No pharmacologic dilation · camera: NIDEK AFC-230
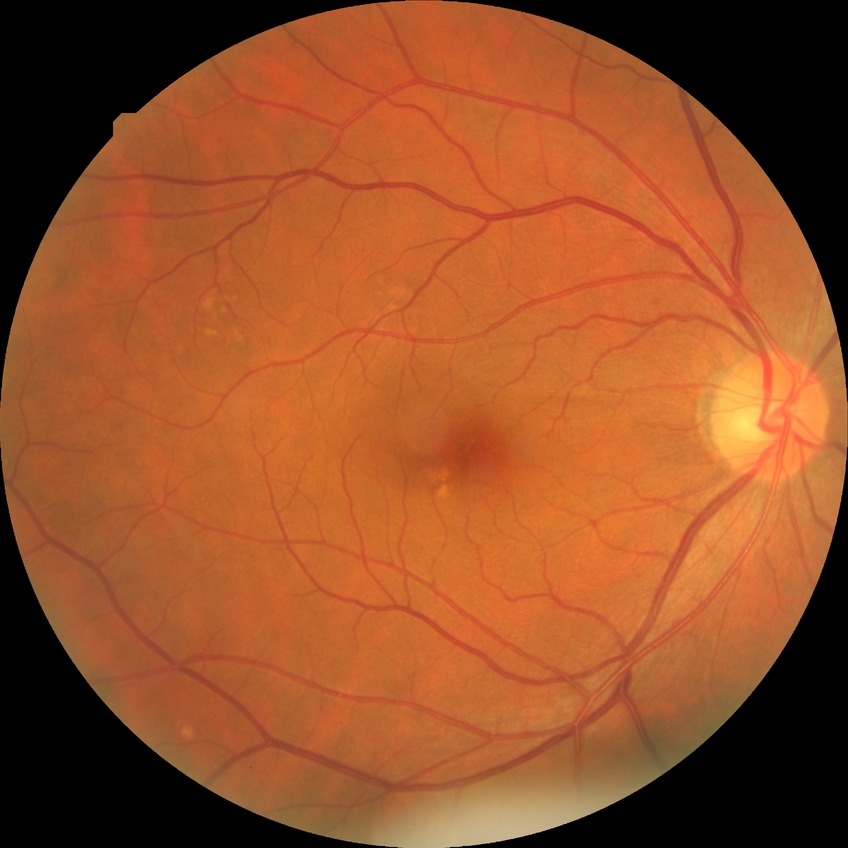

Diabetic retinopathy grade is no diabetic retinopathy.